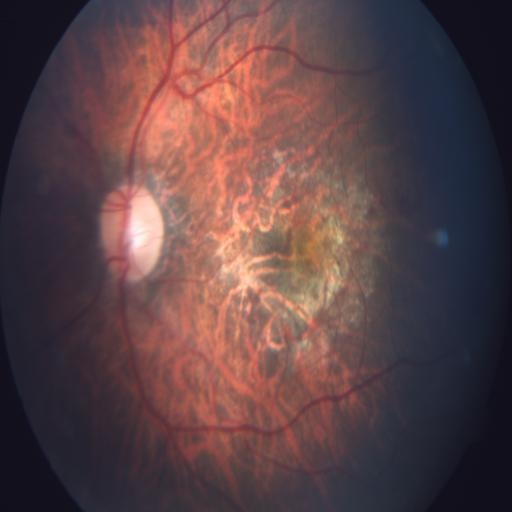 Findings:
- myopia
- tessellation
- macular scar